Camera: Phoenix ICON (100° FOV); pediatric retinal photograph (wide-field); 1240x1240:
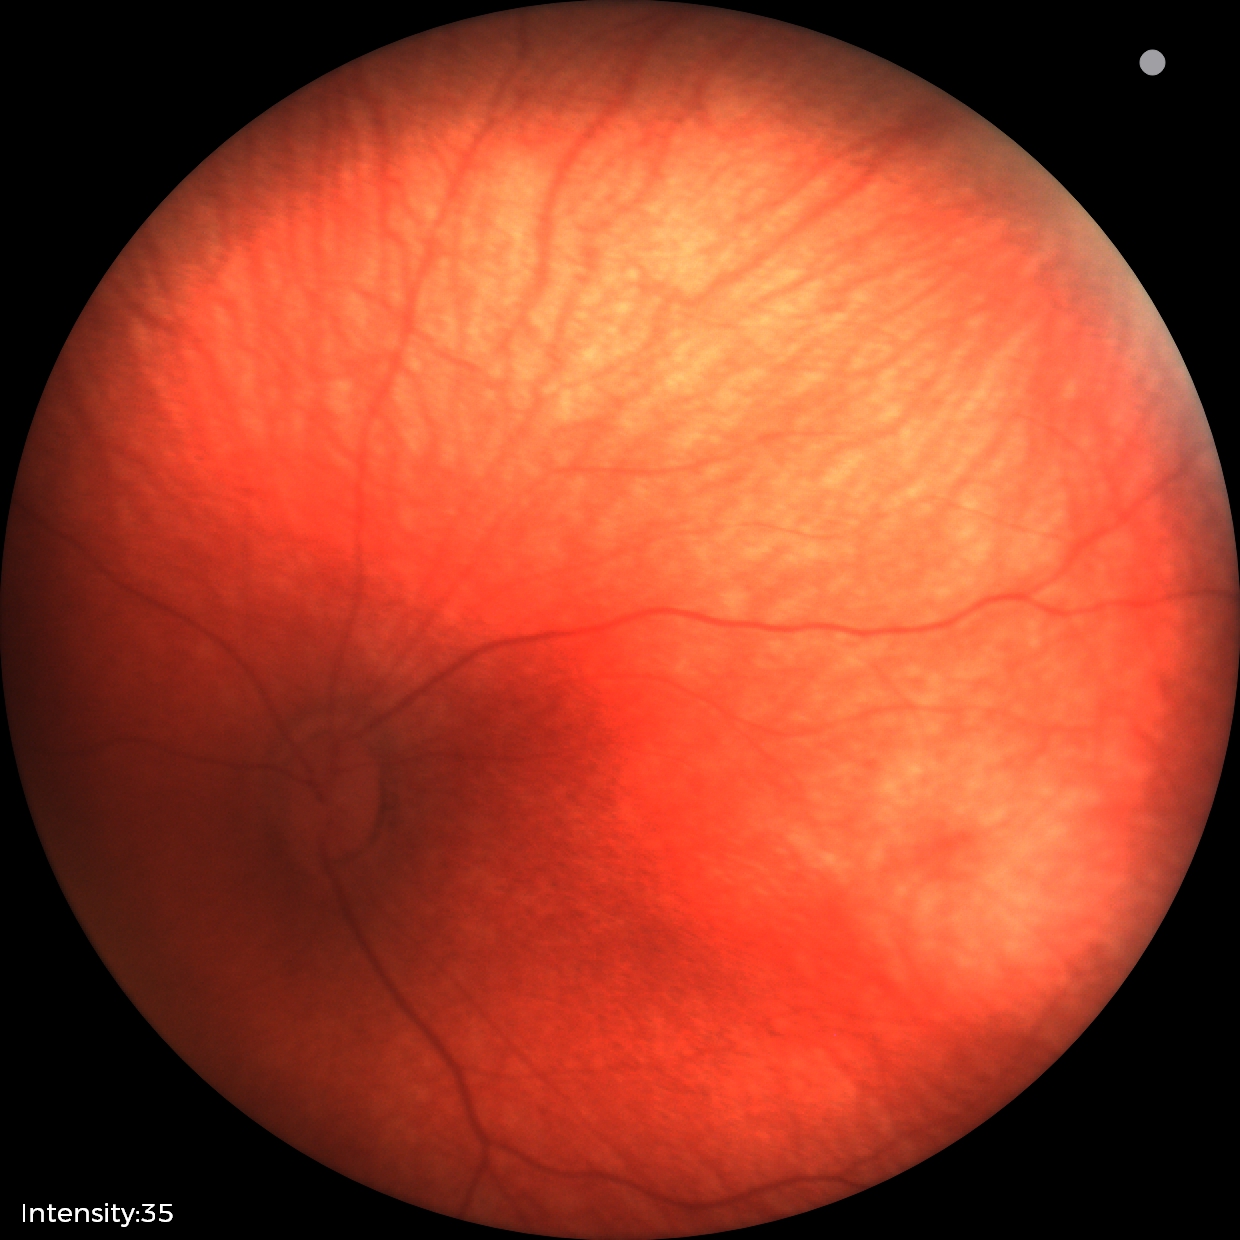

From an examination with diagnosis of retinal hemorrhages.